Fundus photo. FOV: 45 degrees: 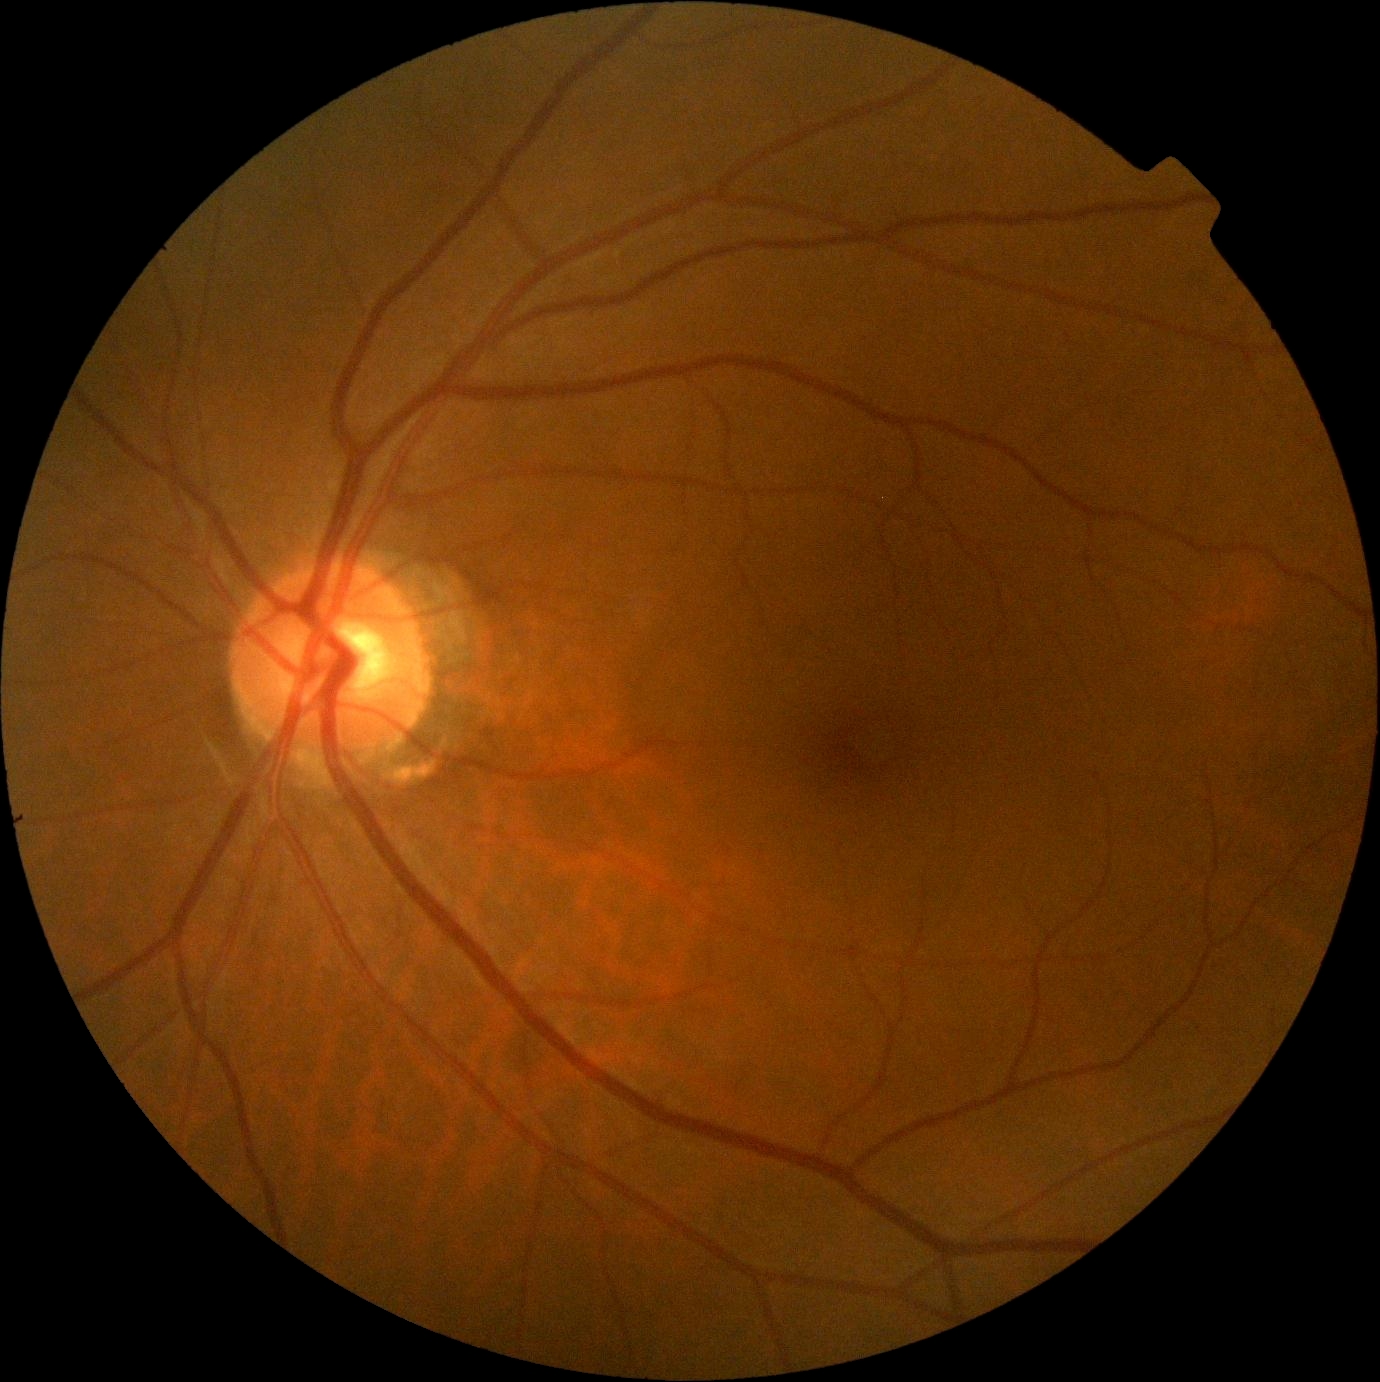

  dr_grade: grade 0 (no apparent retinopathy)
  dr_impression: negative for DR